Remidio Fundus on Phone
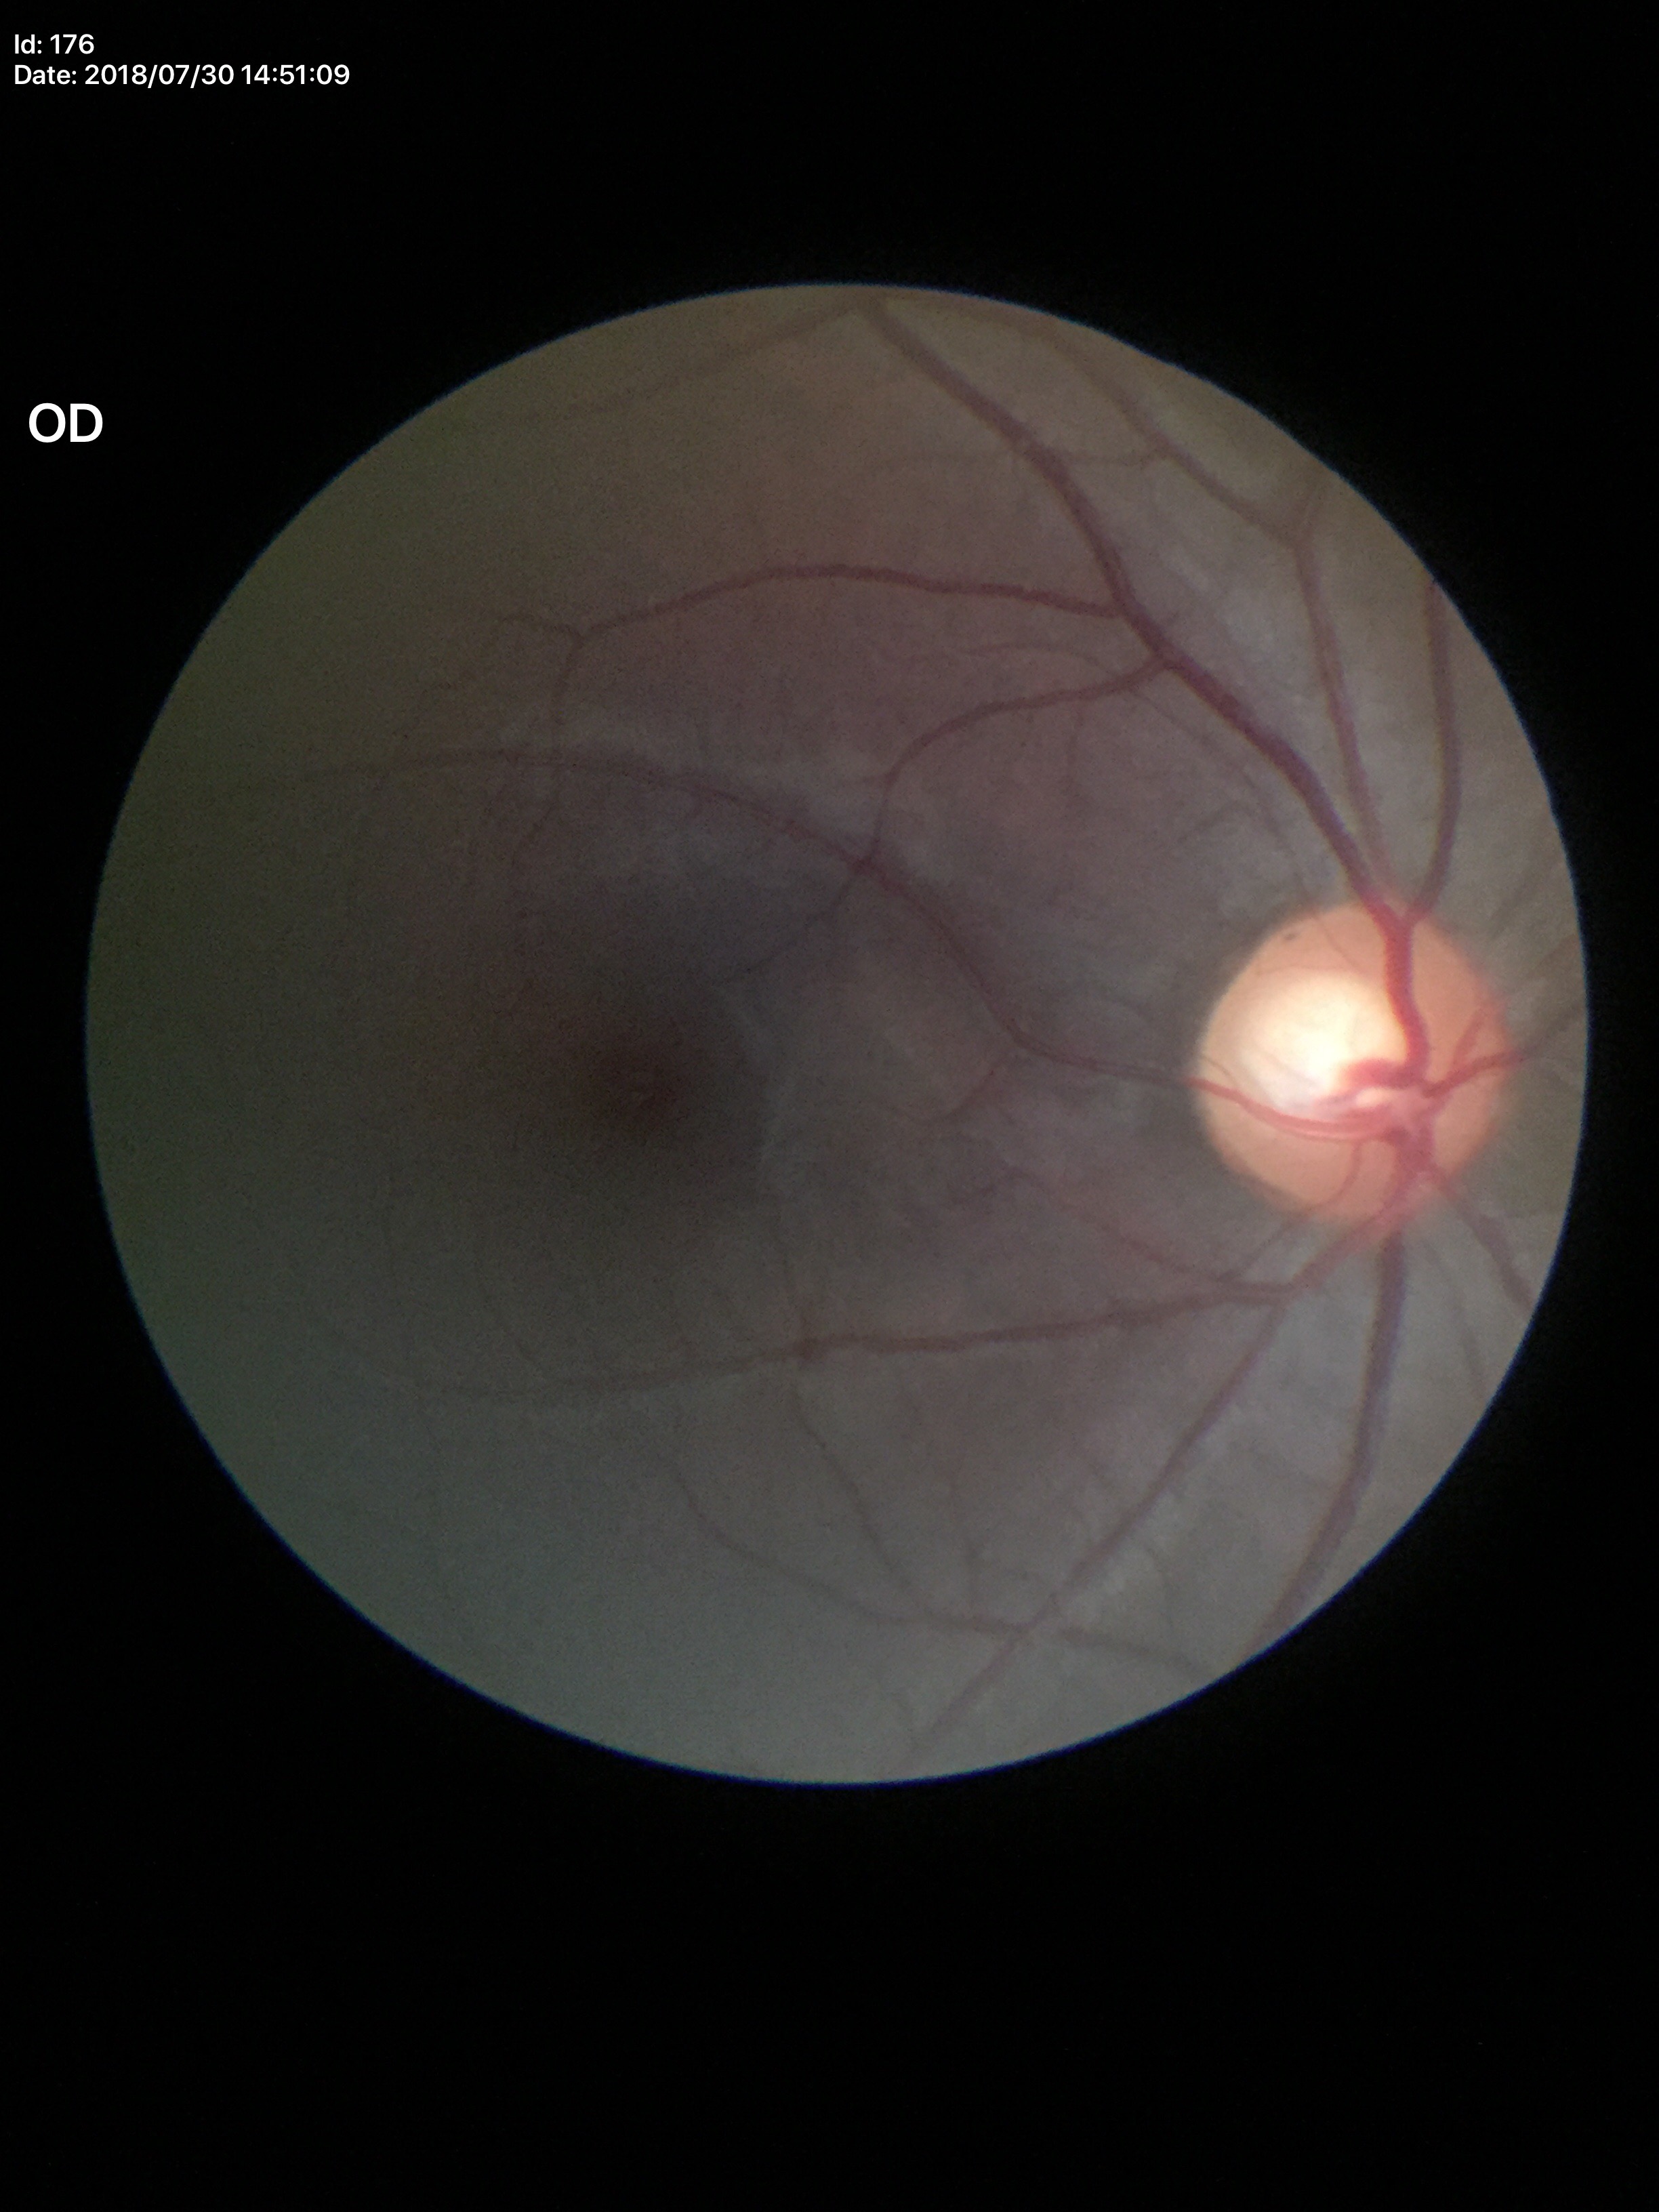
No glaucomatous optic neuropathy. Vertical C/D ratio (VCDR): 0.56.